Color fundus image · 45° FOV · 1380x1382px — 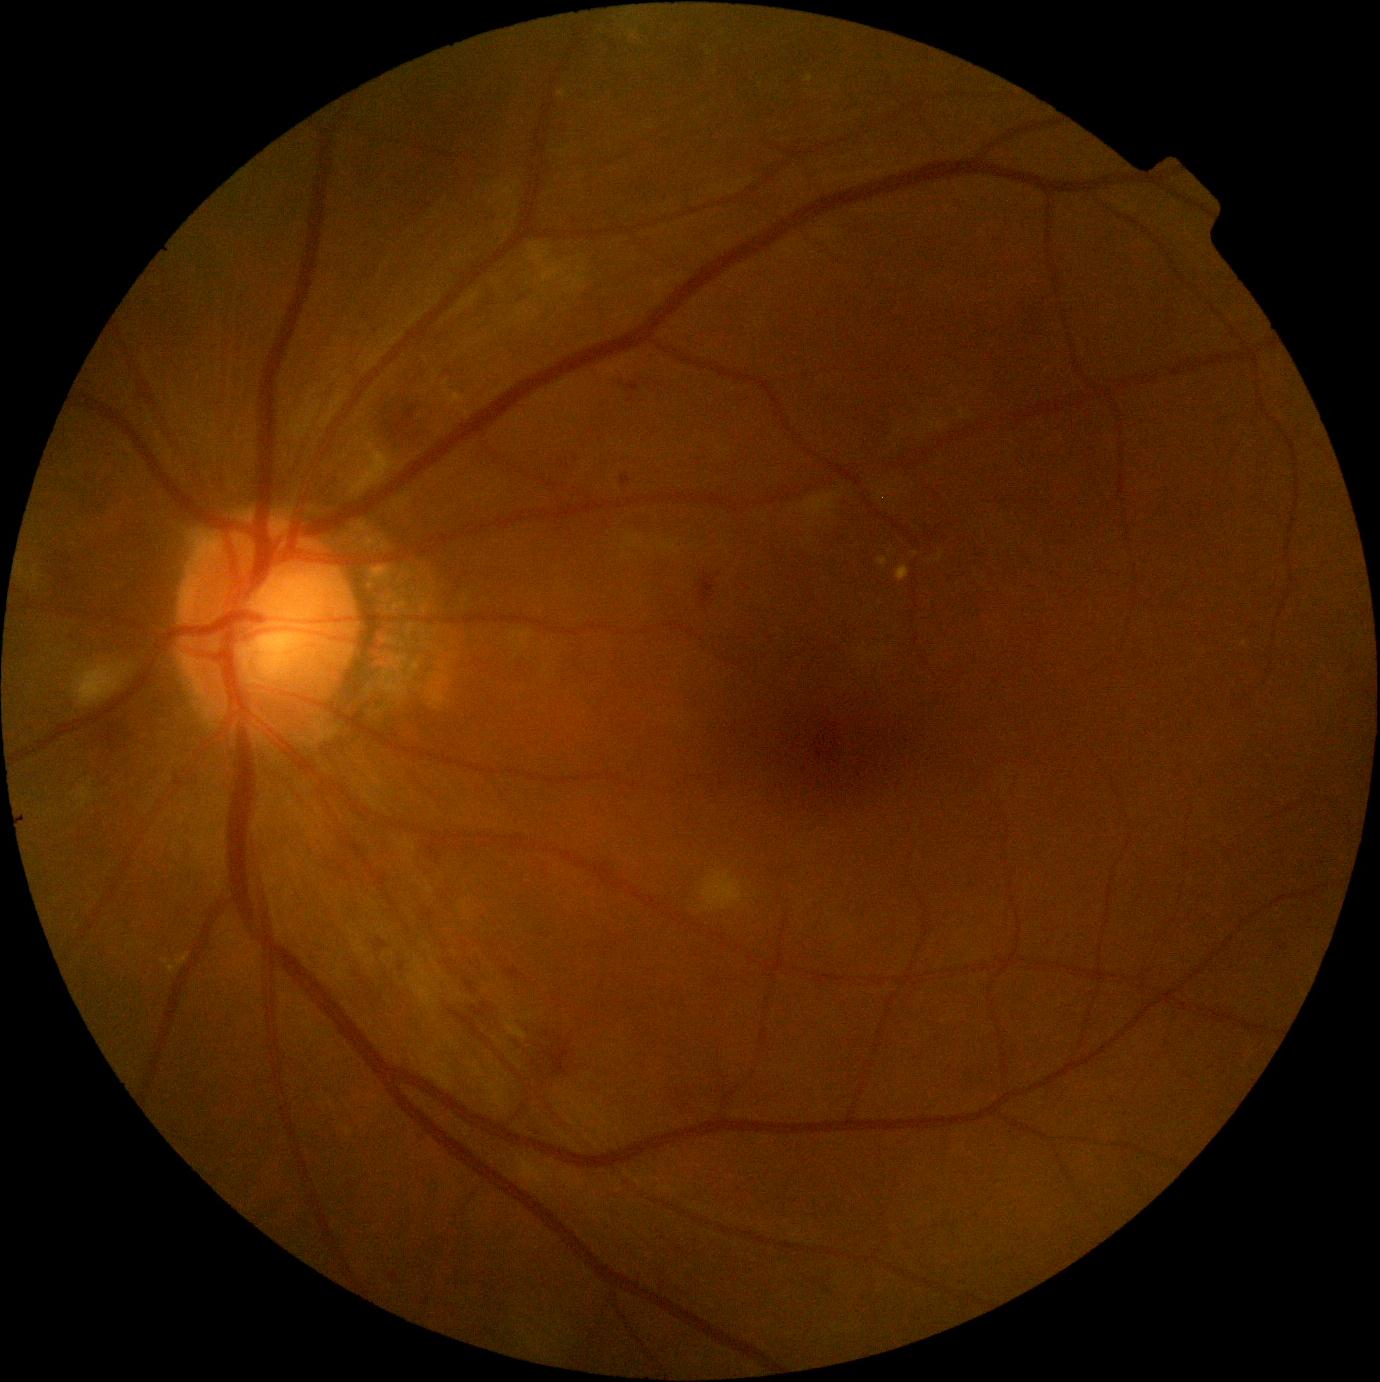

DR: grade 2 (moderate NPDR)
EXs: (left=806, top=76, right=814, bottom=82) | (left=877, top=557, right=888, bottom=568) | (left=629, top=31, right=640, bottom=41) | (left=558, top=90, right=567, bottom=100) | (left=442, top=380, right=449, bottom=388) | (left=444, top=389, right=467, bottom=407) | (left=161, top=953, right=191, bottom=974) | (left=896, top=565, right=911, bottom=581)
MAs: (left=621, top=476, right=631, bottom=486) | (left=627, top=382, right=639, bottom=393)
HEs: (left=378, top=939, right=389, bottom=949) | (left=506, top=967, right=529, bottom=983) | (left=483, top=1004, right=491, bottom=1012) | (left=101, top=719, right=138, bottom=750) | (left=515, top=1016, right=574, bottom=1078) | (left=464, top=978, right=479, bottom=993) | (left=698, top=573, right=716, bottom=606) | (left=471, top=1006, right=487, bottom=1017)
SEs: (left=409, top=971, right=437, bottom=1012) | (left=73, top=662, right=121, bottom=708) | (left=350, top=460, right=380, bottom=494) | (left=506, top=1016, right=527, bottom=1040) | (left=415, top=958, right=422, bottom=971) | (left=701, top=870, right=744, bottom=912)
Additional small SEs near x=80 y=668